2089x1764.
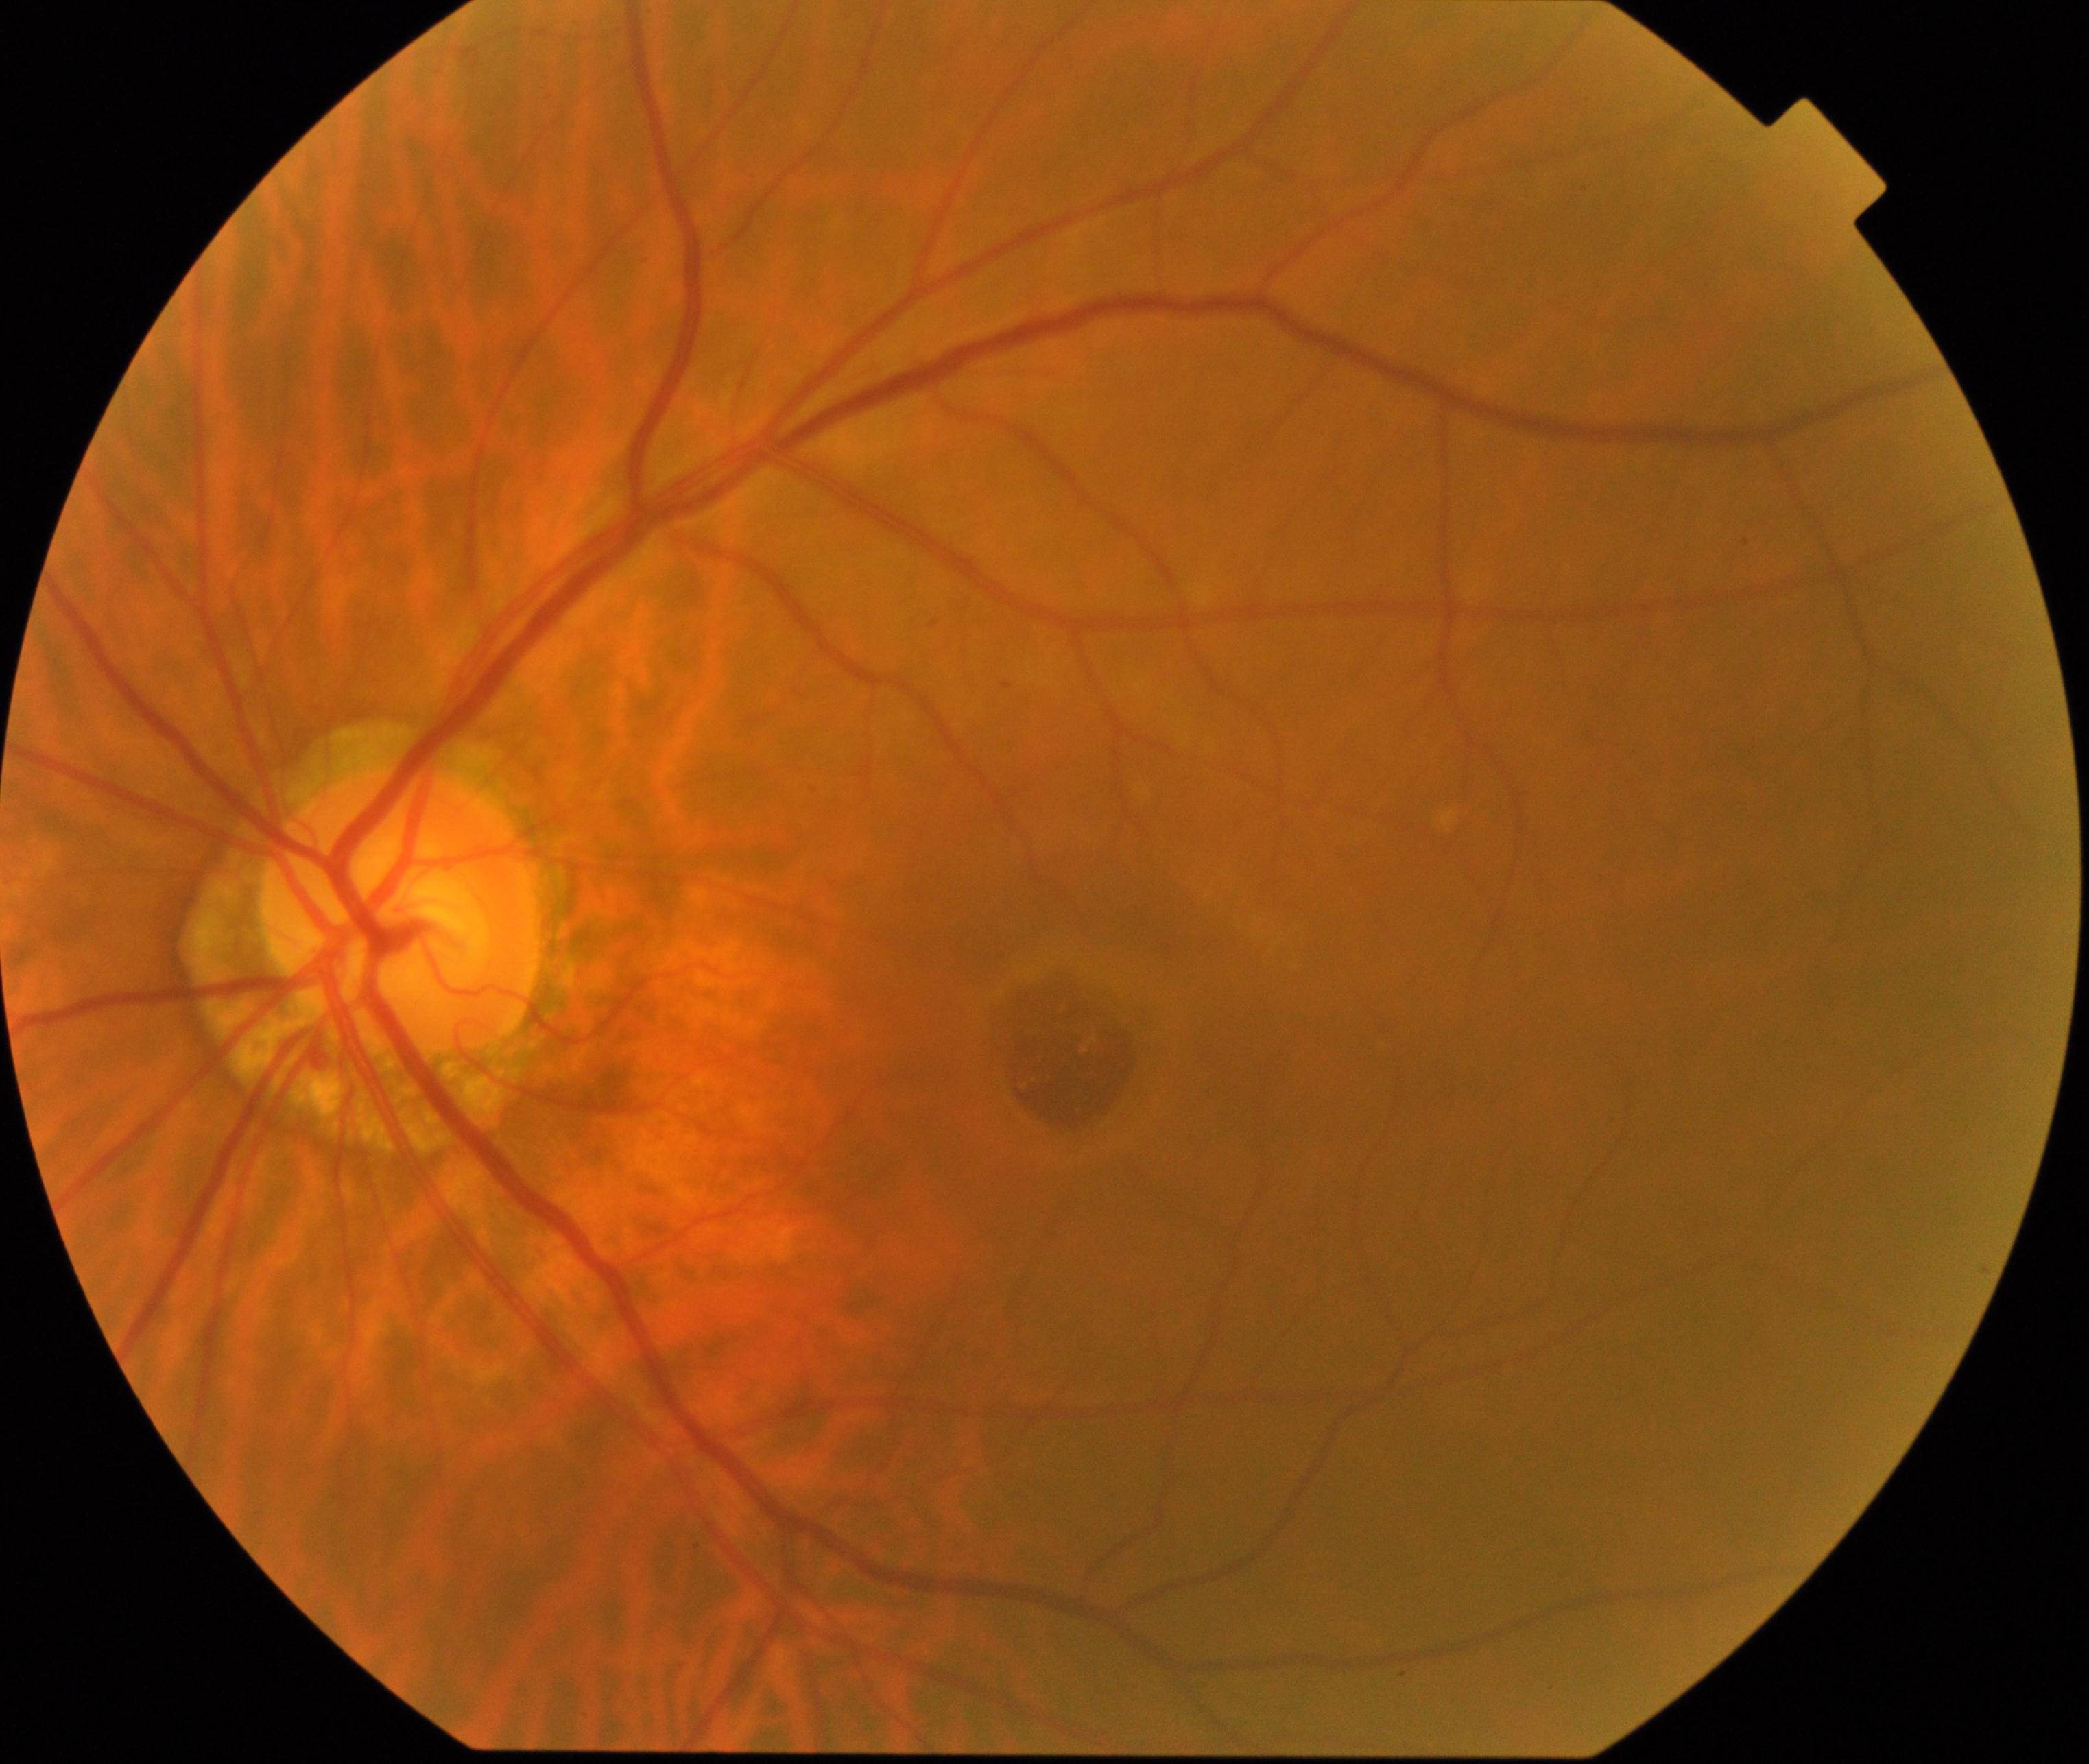

Appearance consistent with macular hole.